Without pupil dilation, 848x848px, FOV: 45 degrees: 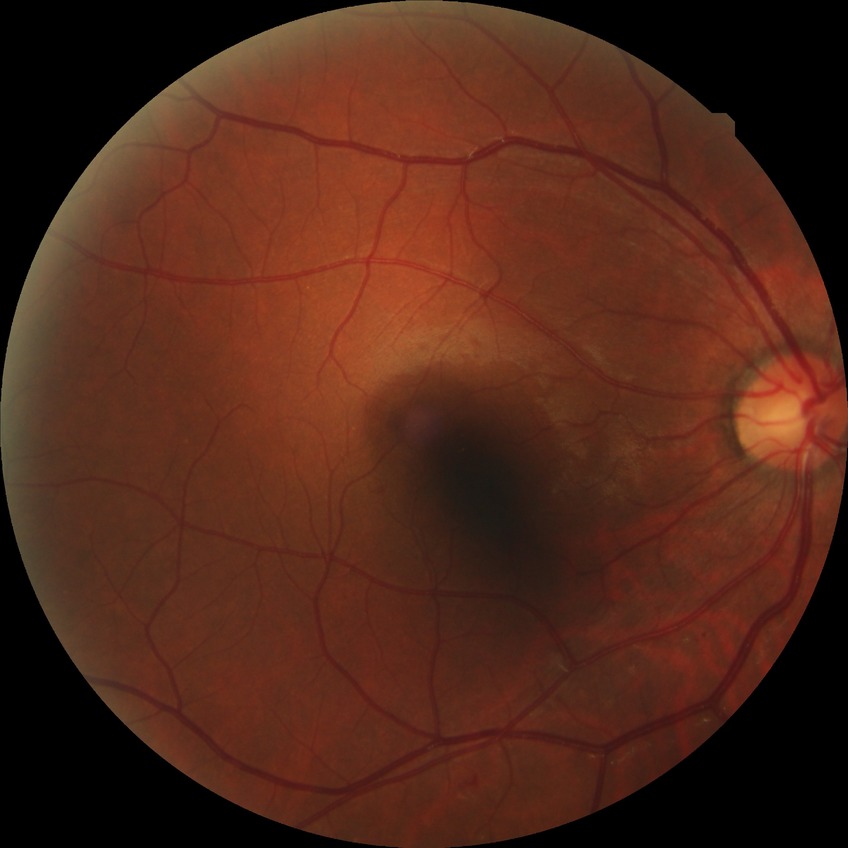

{"davis_grade": "simple diabetic retinopathy"}